Optic disc-centered crop from a color fundus photograph.
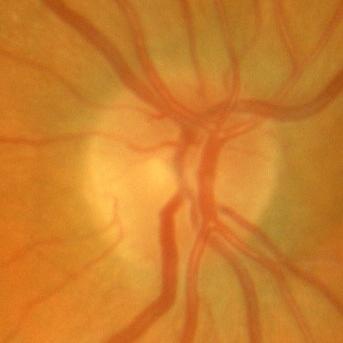 Q: What is the glaucoma diagnosis?
A: No glaucomatous changes.